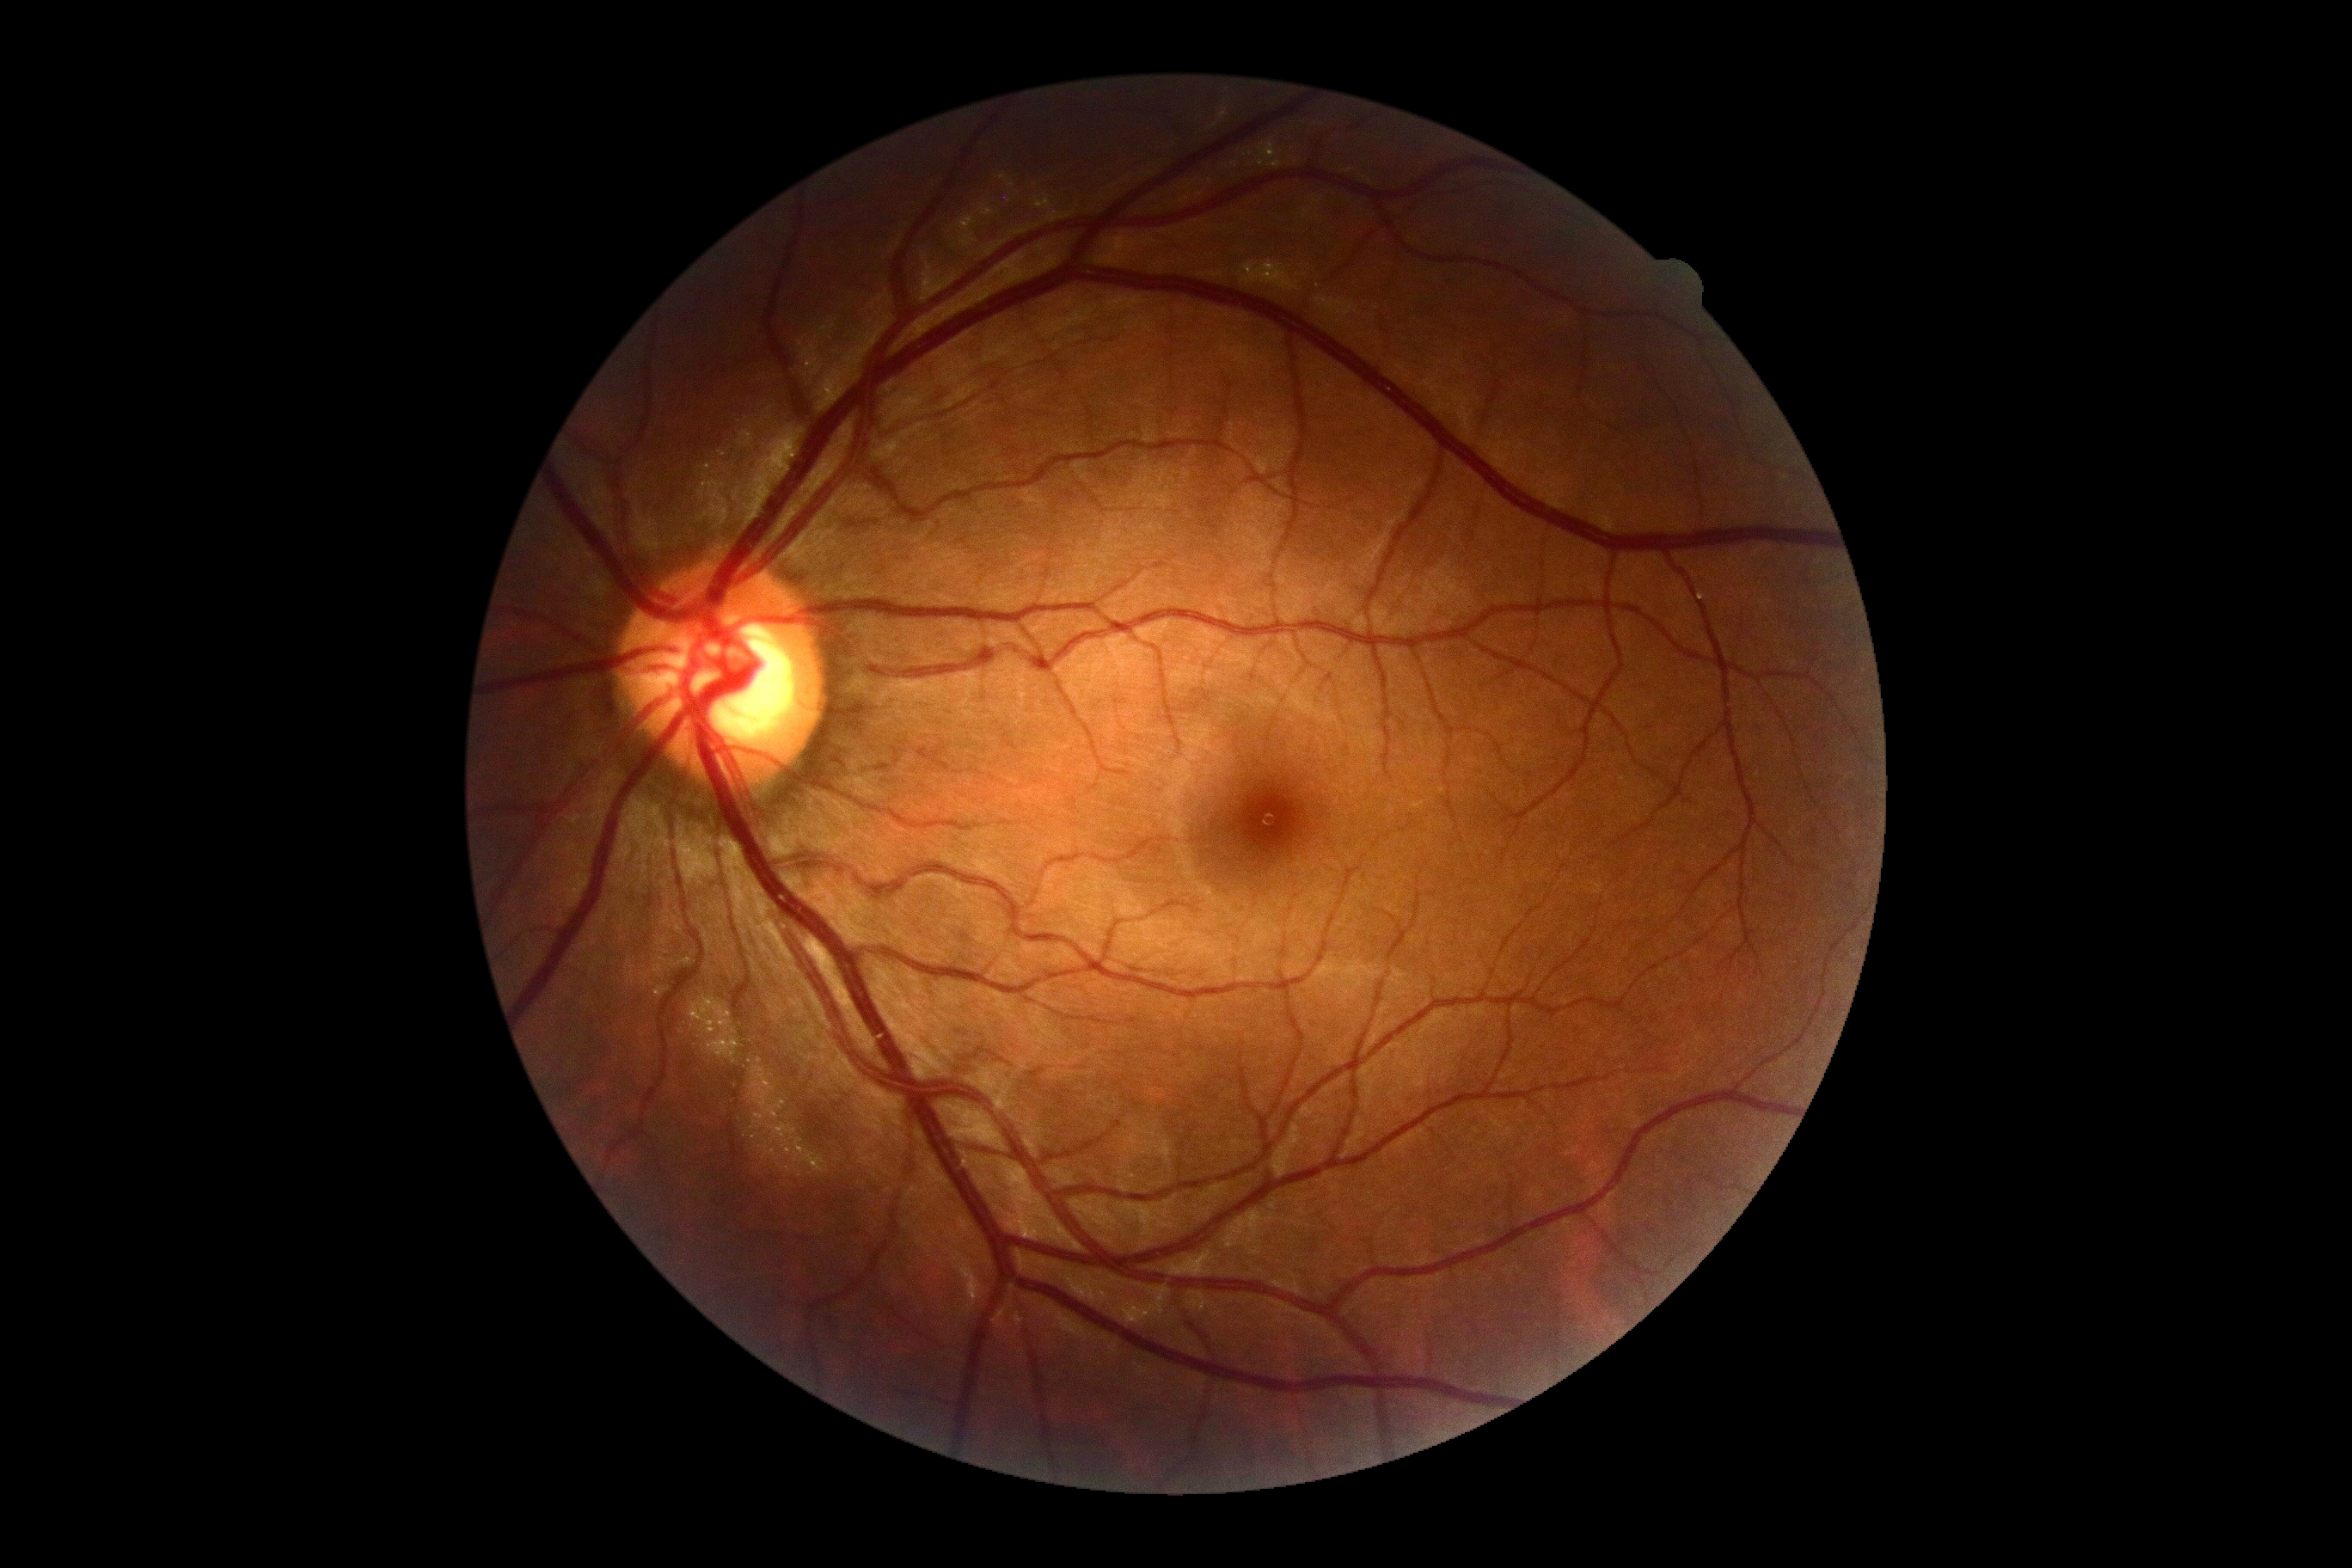

Retinopathy grade: 0 (no apparent retinopathy). No DR findings.